Without pupil dilation, diabetic retinopathy graded by the modified Davis classification: 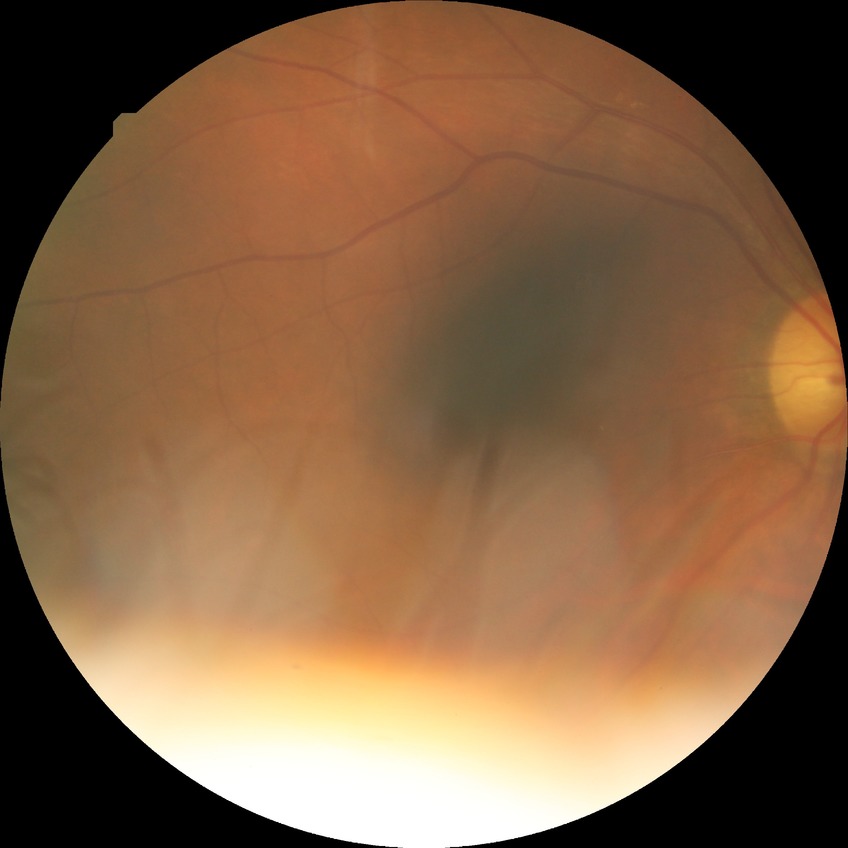 diabetic retinopathy (DR)@no diabetic retinopathy (NDR).